2089x1764px. Retinal fundus photograph — 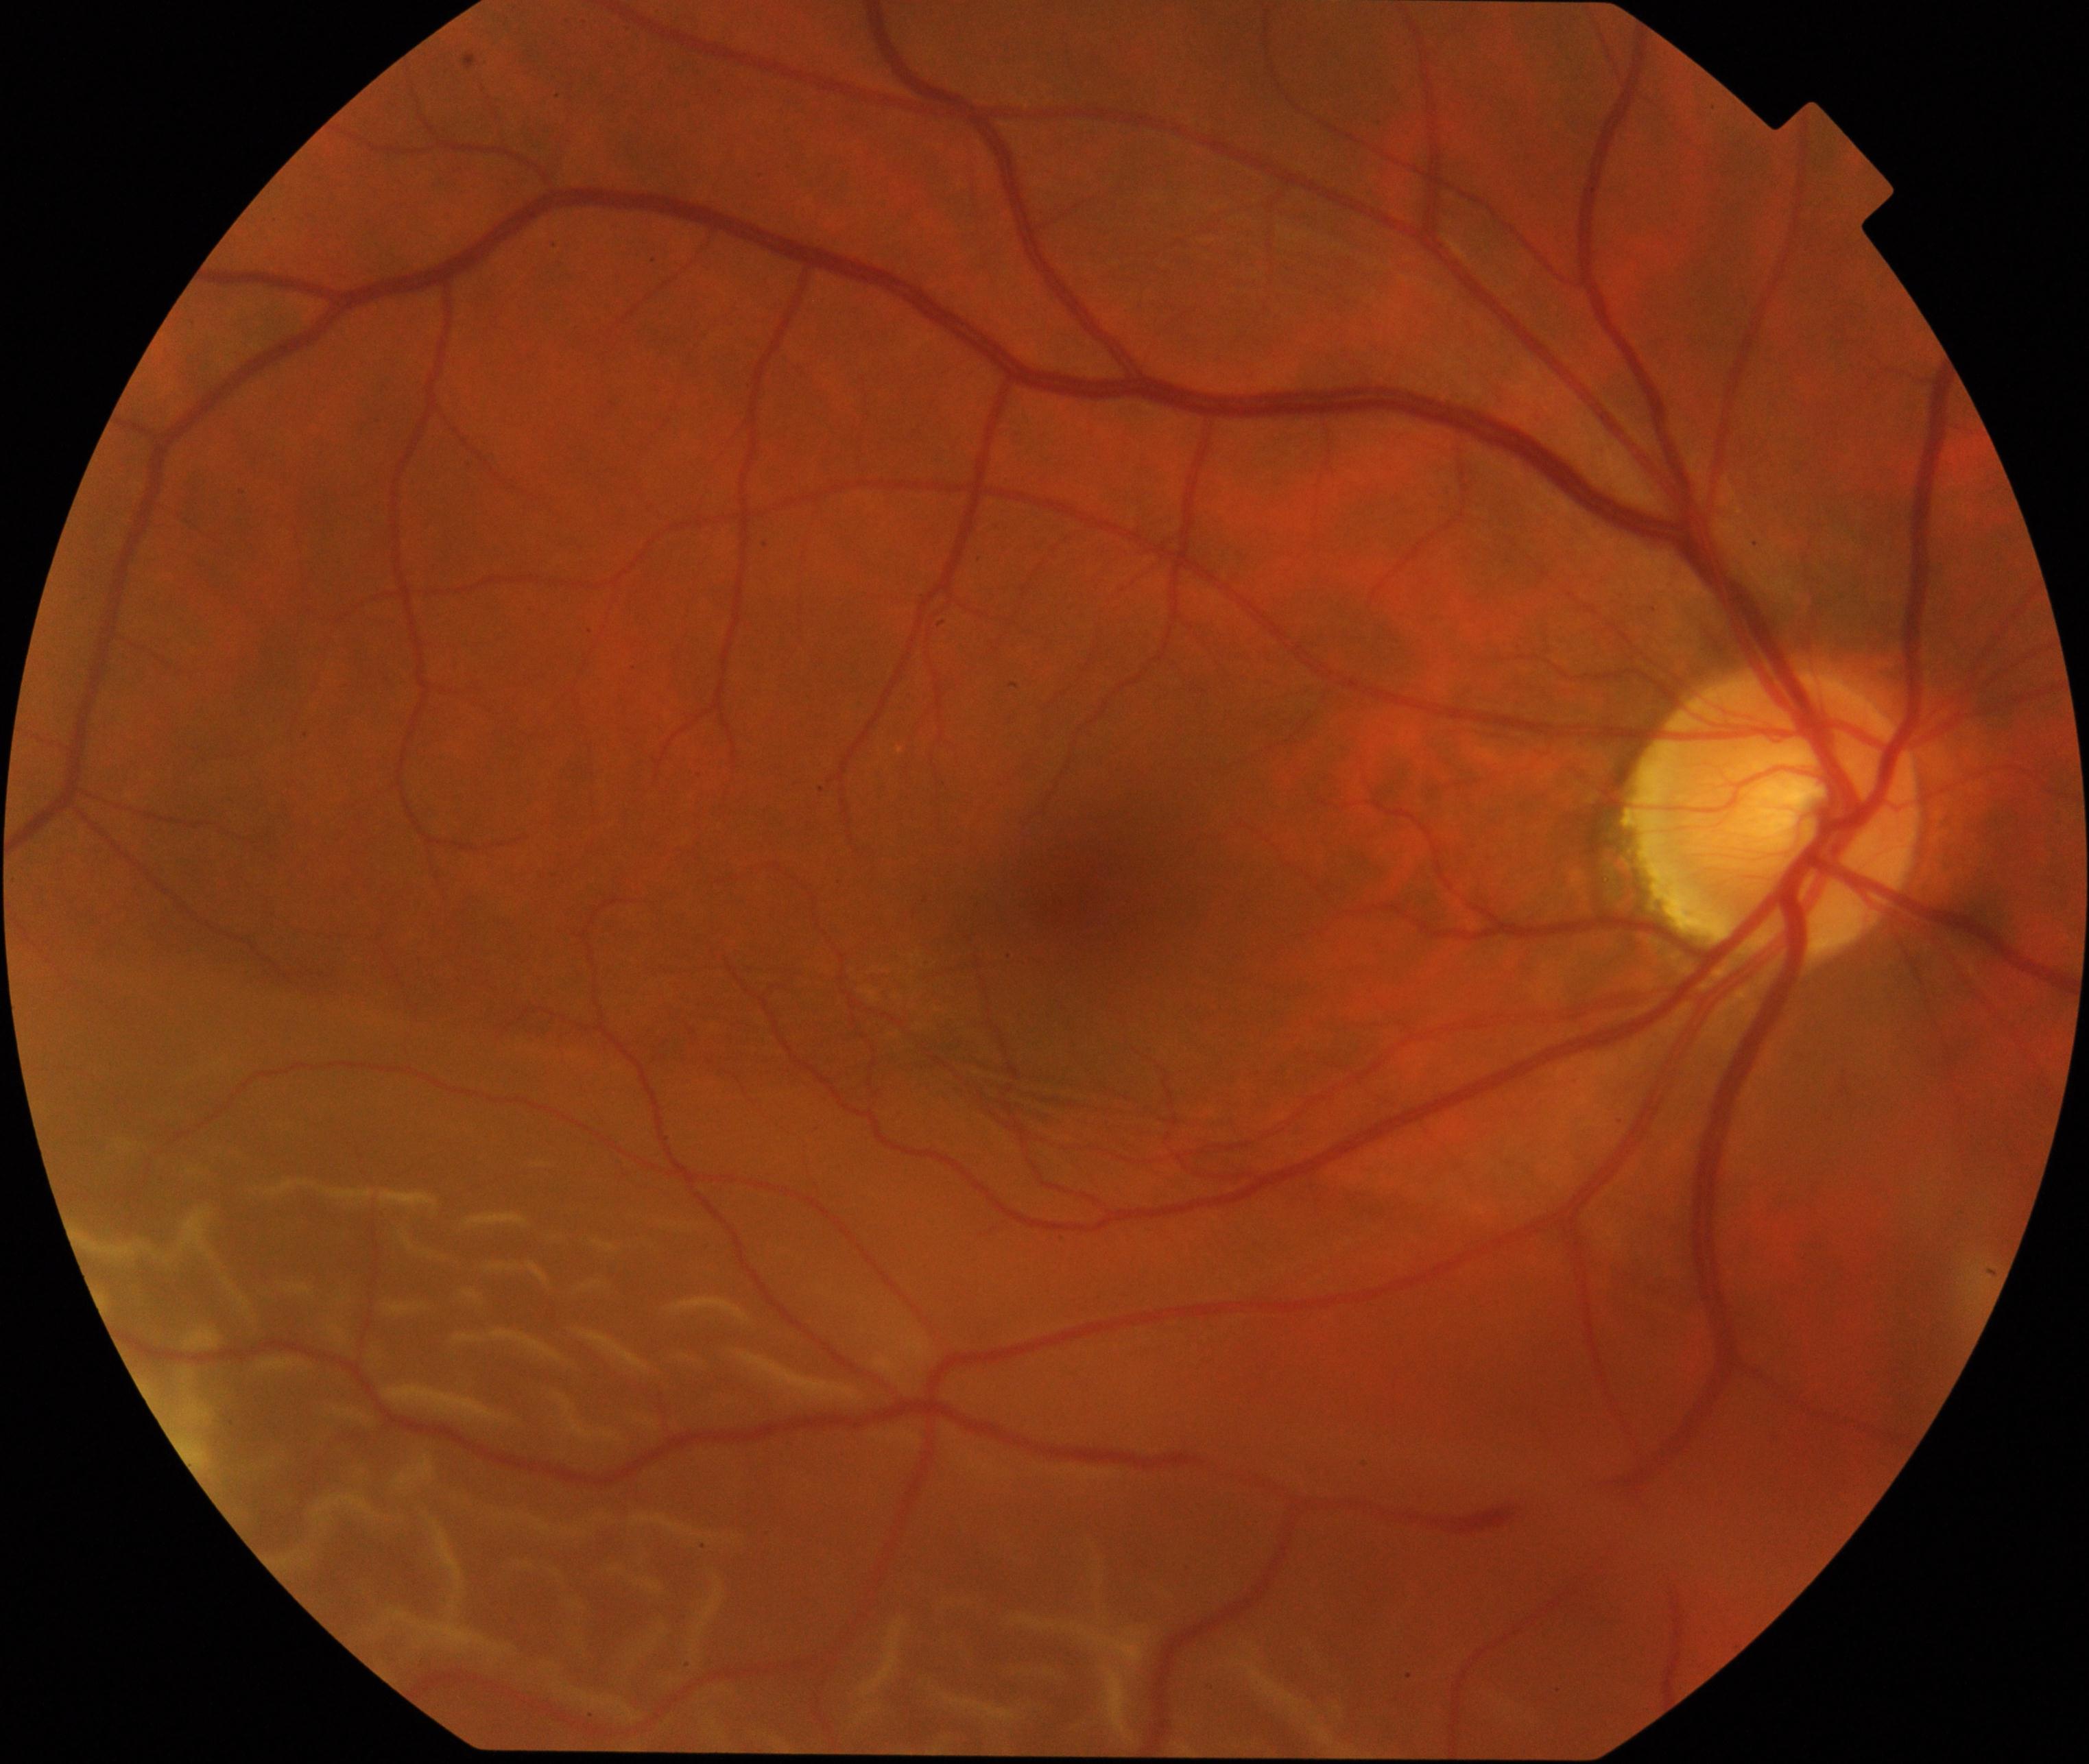

Primary finding: rhegmatogenous retinal detachment. Typically showing slightly opaque, convex or corrugated appearance of elevated retina, sometimes with retinal breaks in view.